Infant wide-field retinal image · camera: Phoenix ICON (100° FOV) — 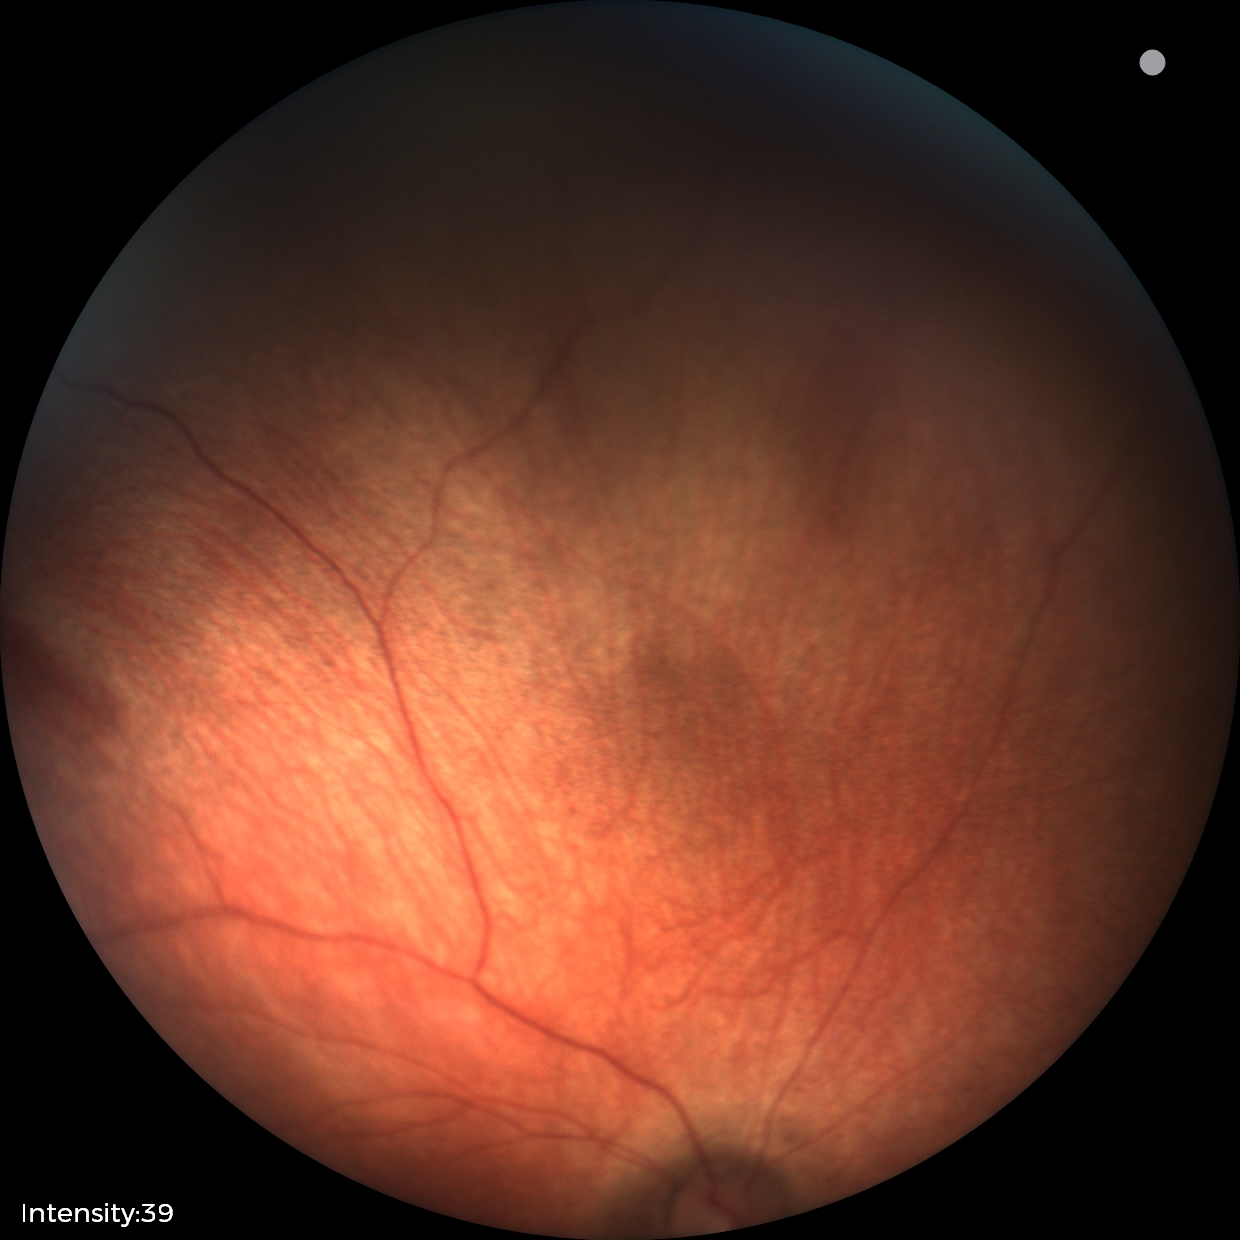 Examination with physiological retinal findings.